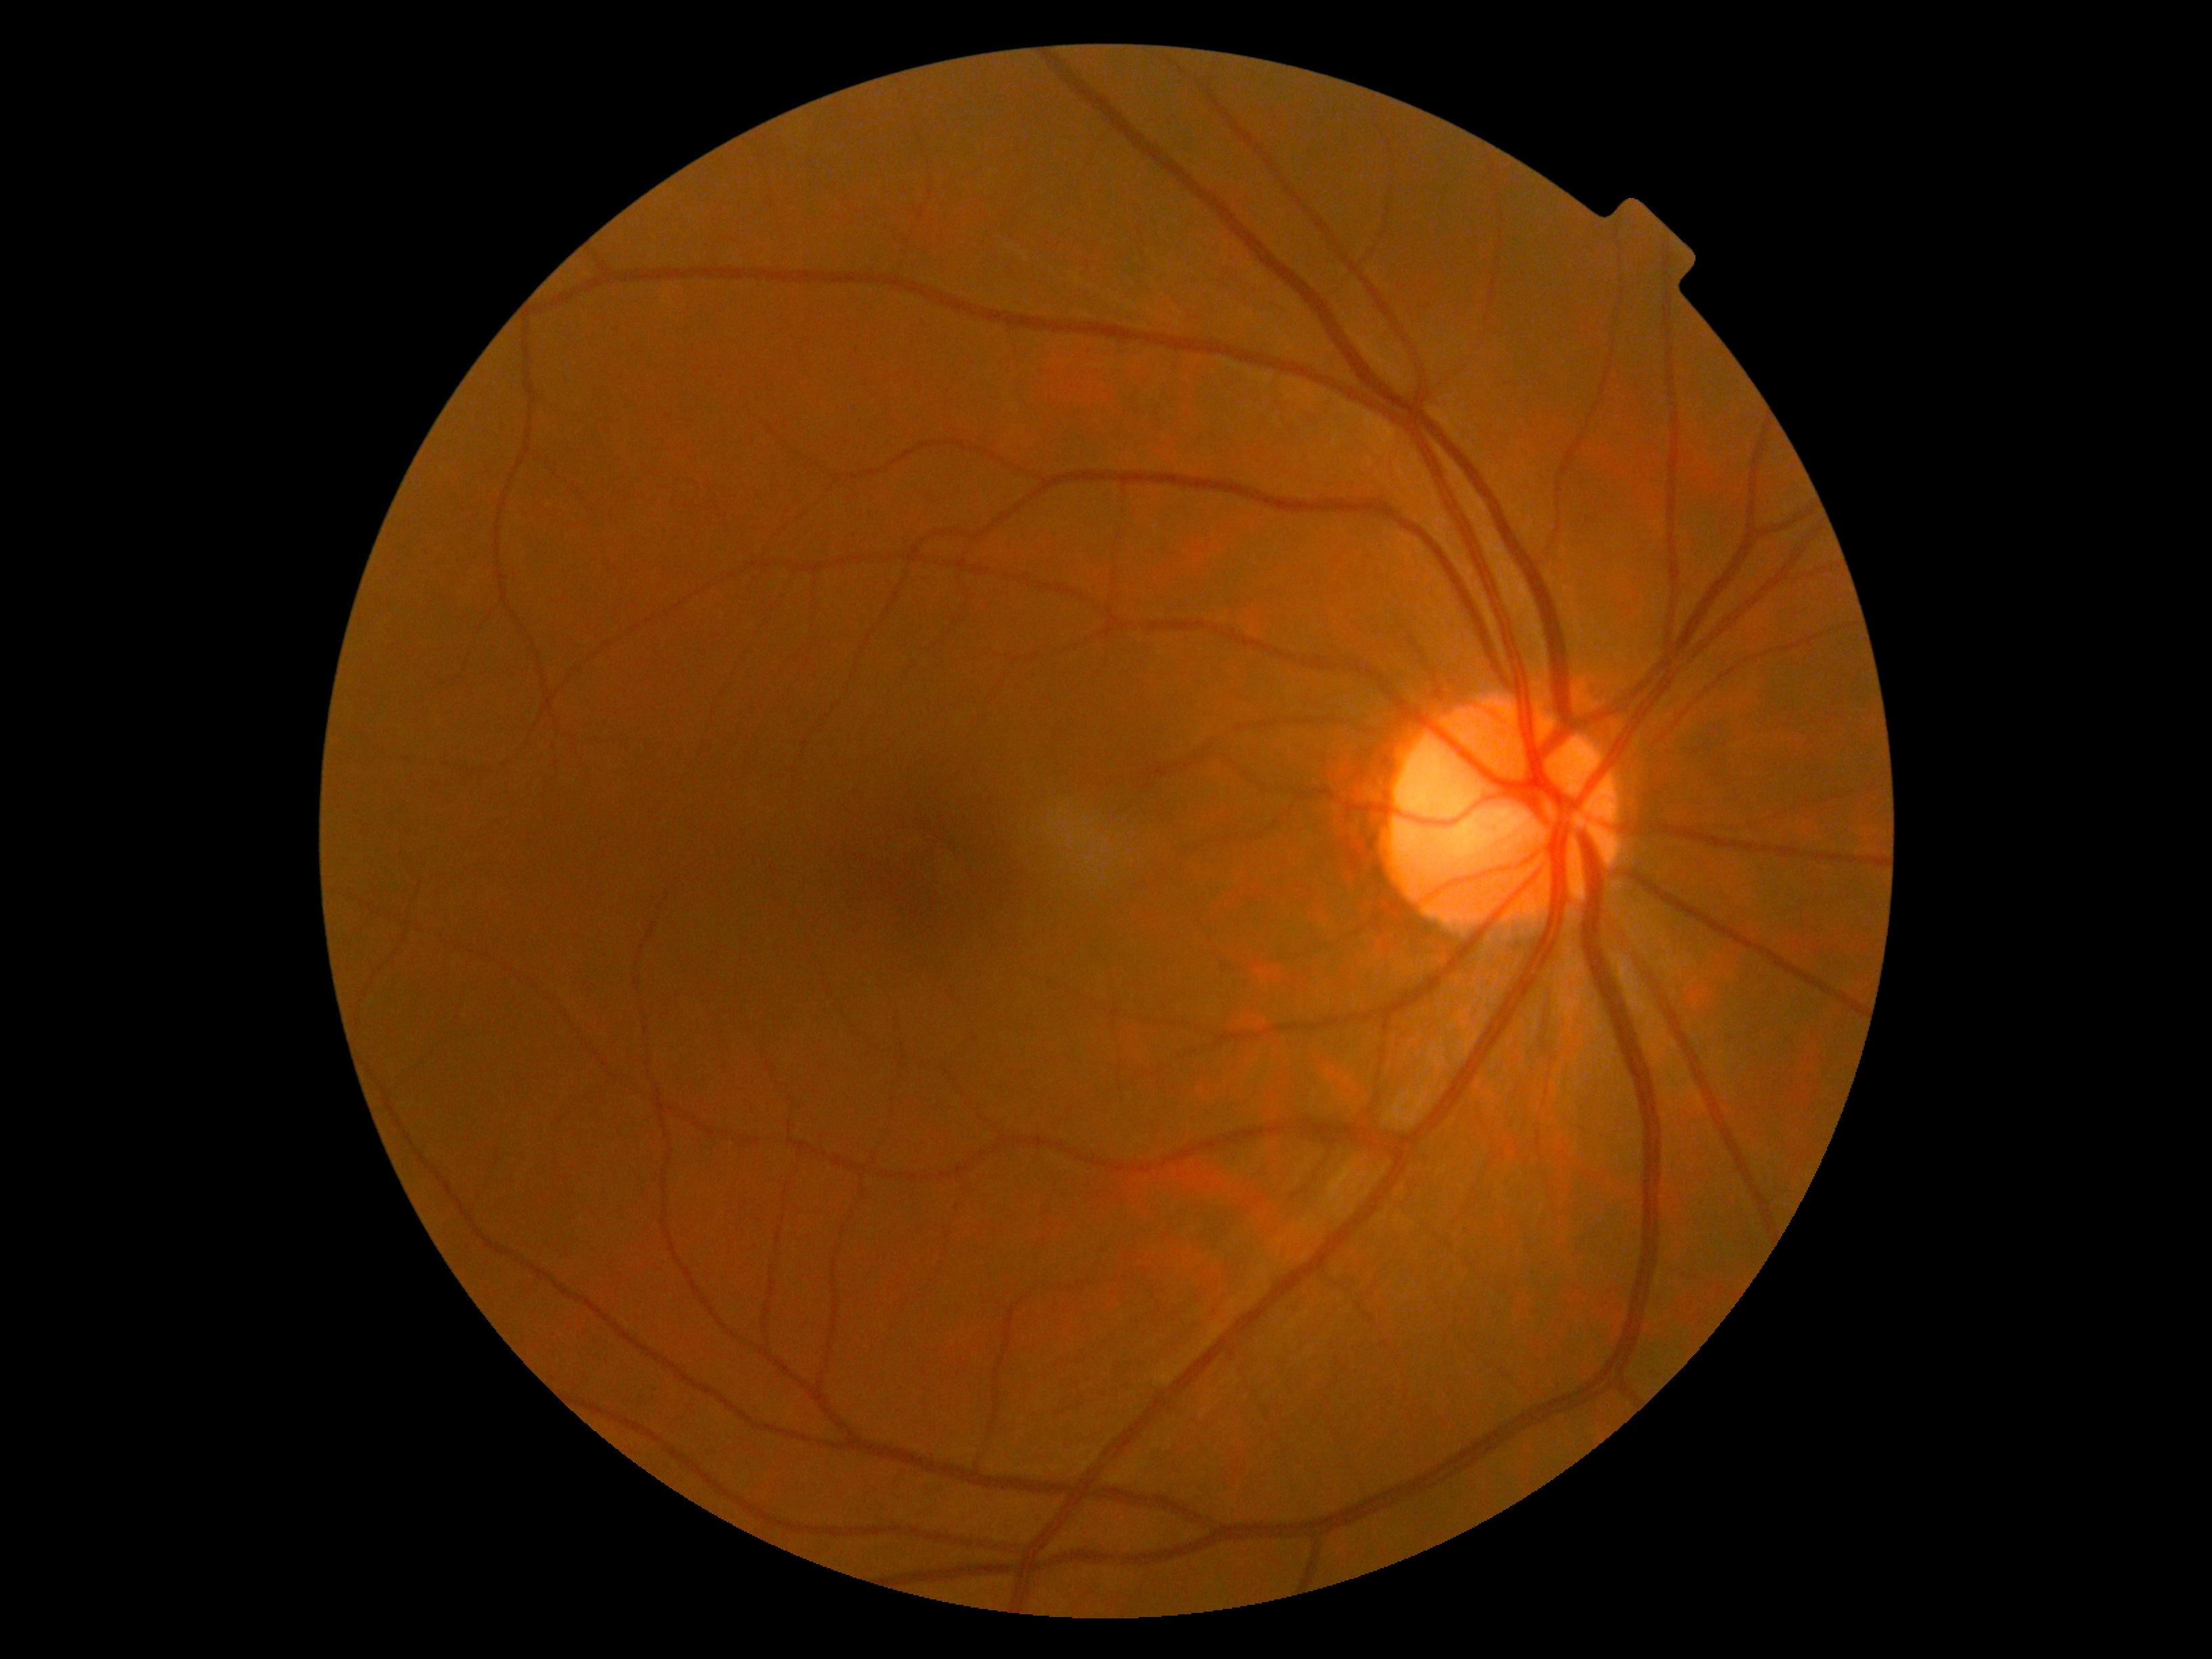
No DR findings. DR grade is 0/4.